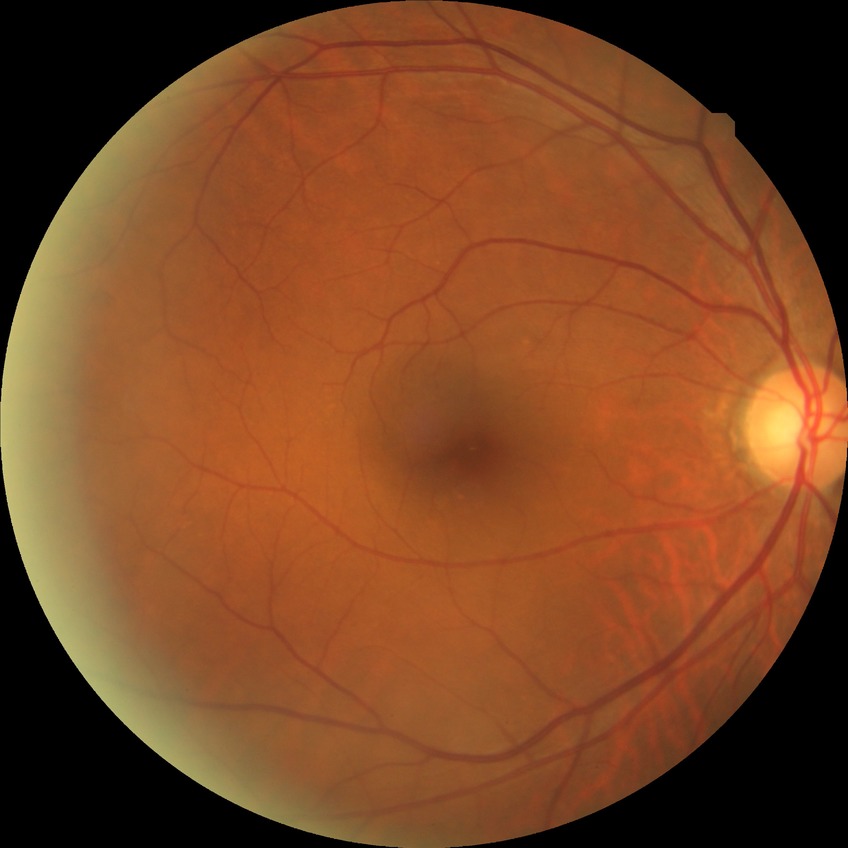

Davis stage: NDR.